NIDEK AFC-230 · posterior pole color fundus photograph · 45-degree field of view · 848 x 848 pixels.
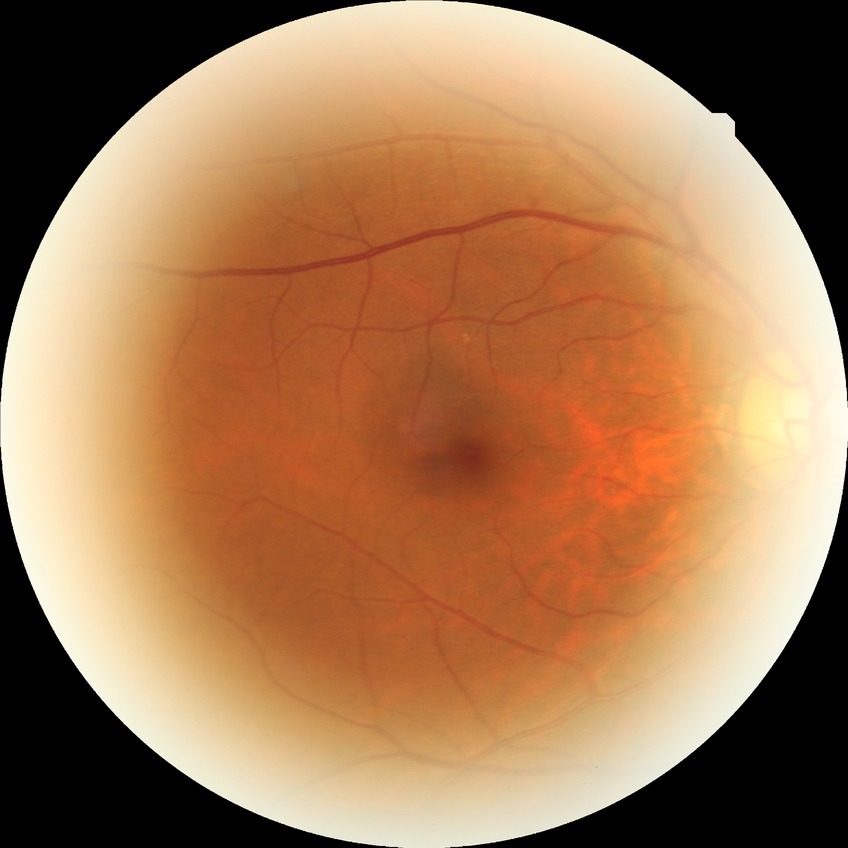
Diabetic retinopathy severity: no diabetic retinopathy.